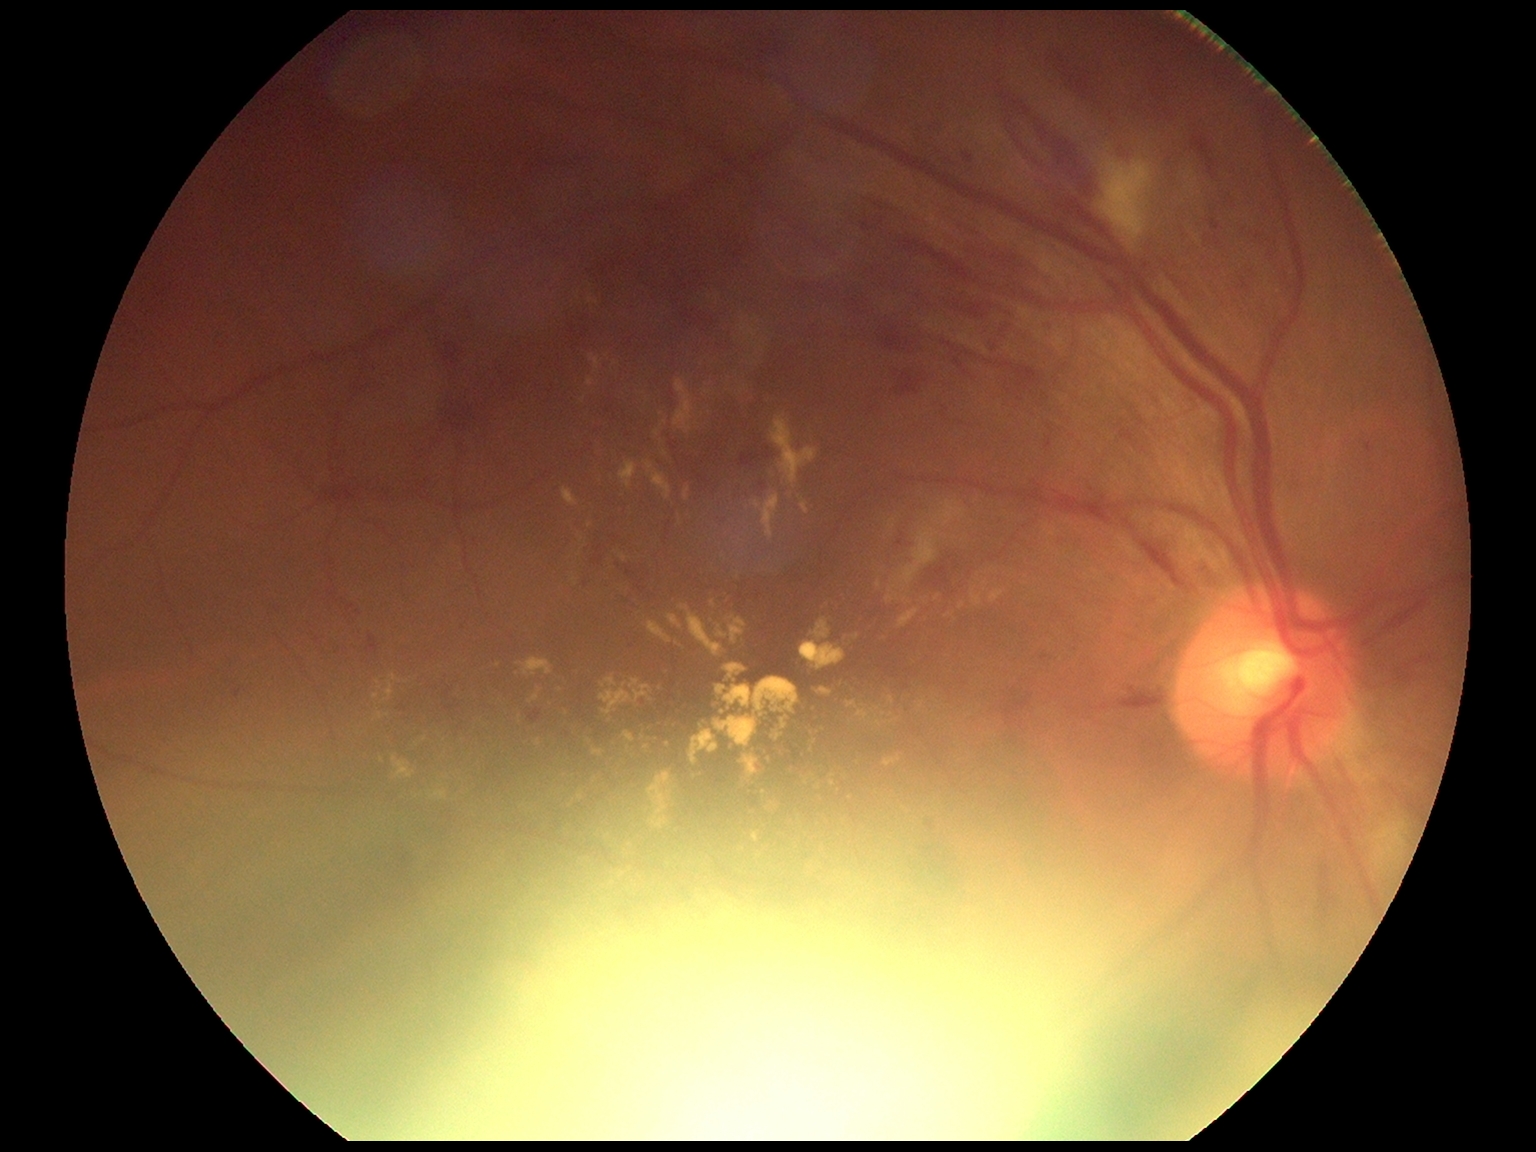 Diabetic retinopathy is moderate non-proliferative diabetic retinopathy (grade 2).